Wide-field fundus photograph of an infant
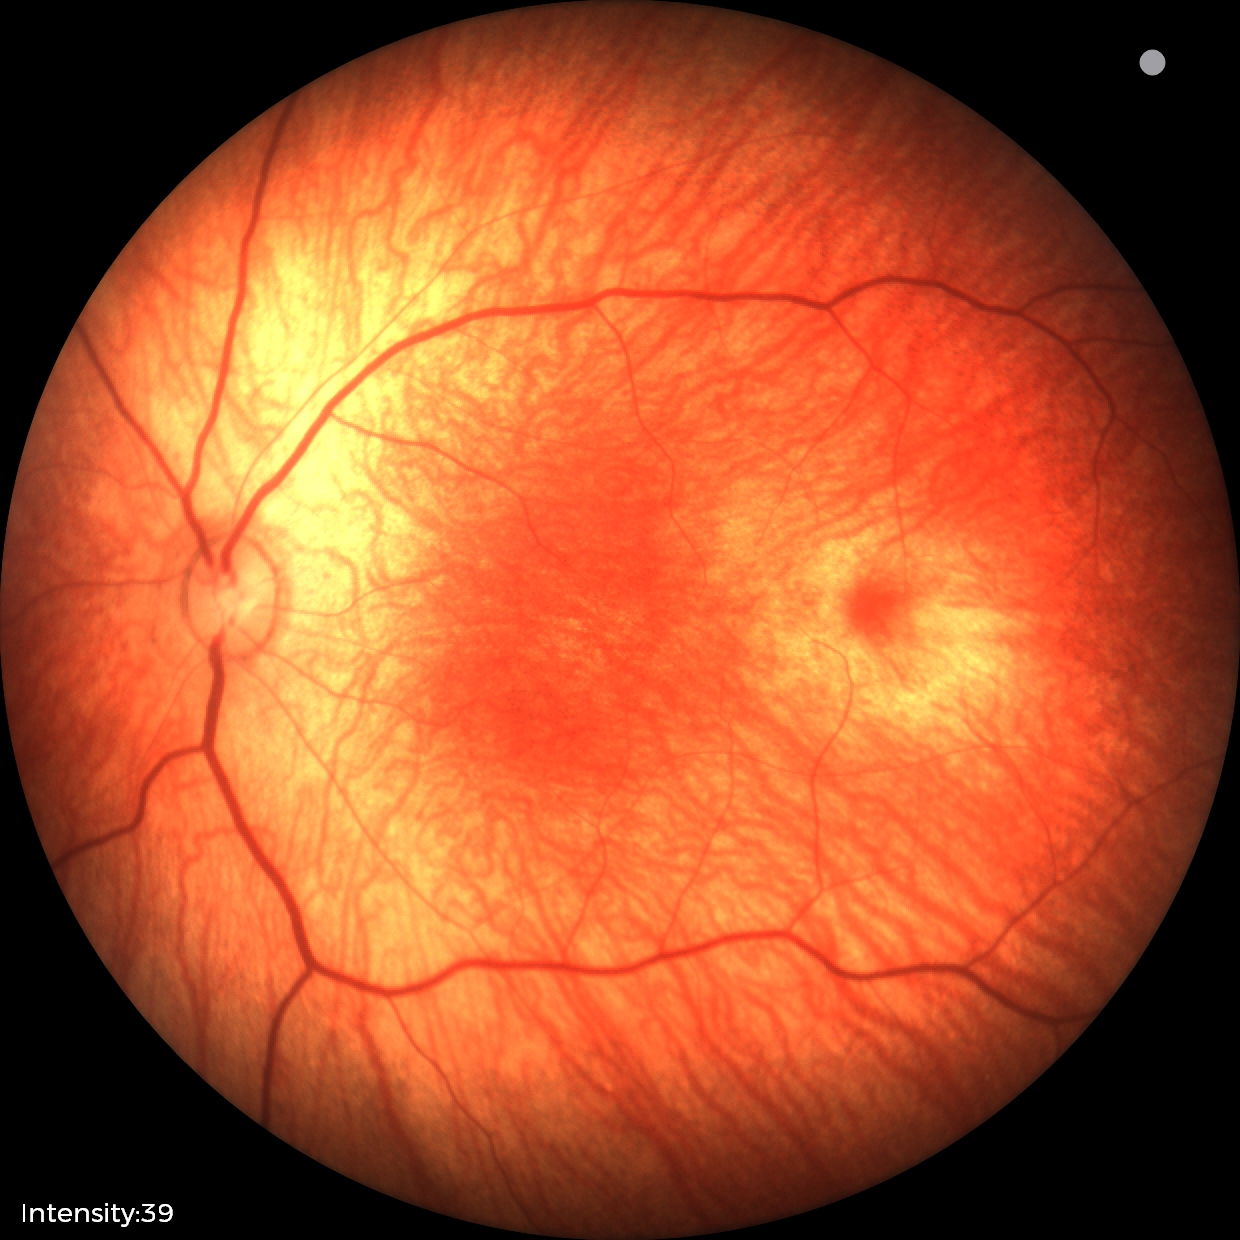
Screening: physiological retinal finding.